Wide-field fundus photograph of an infant: 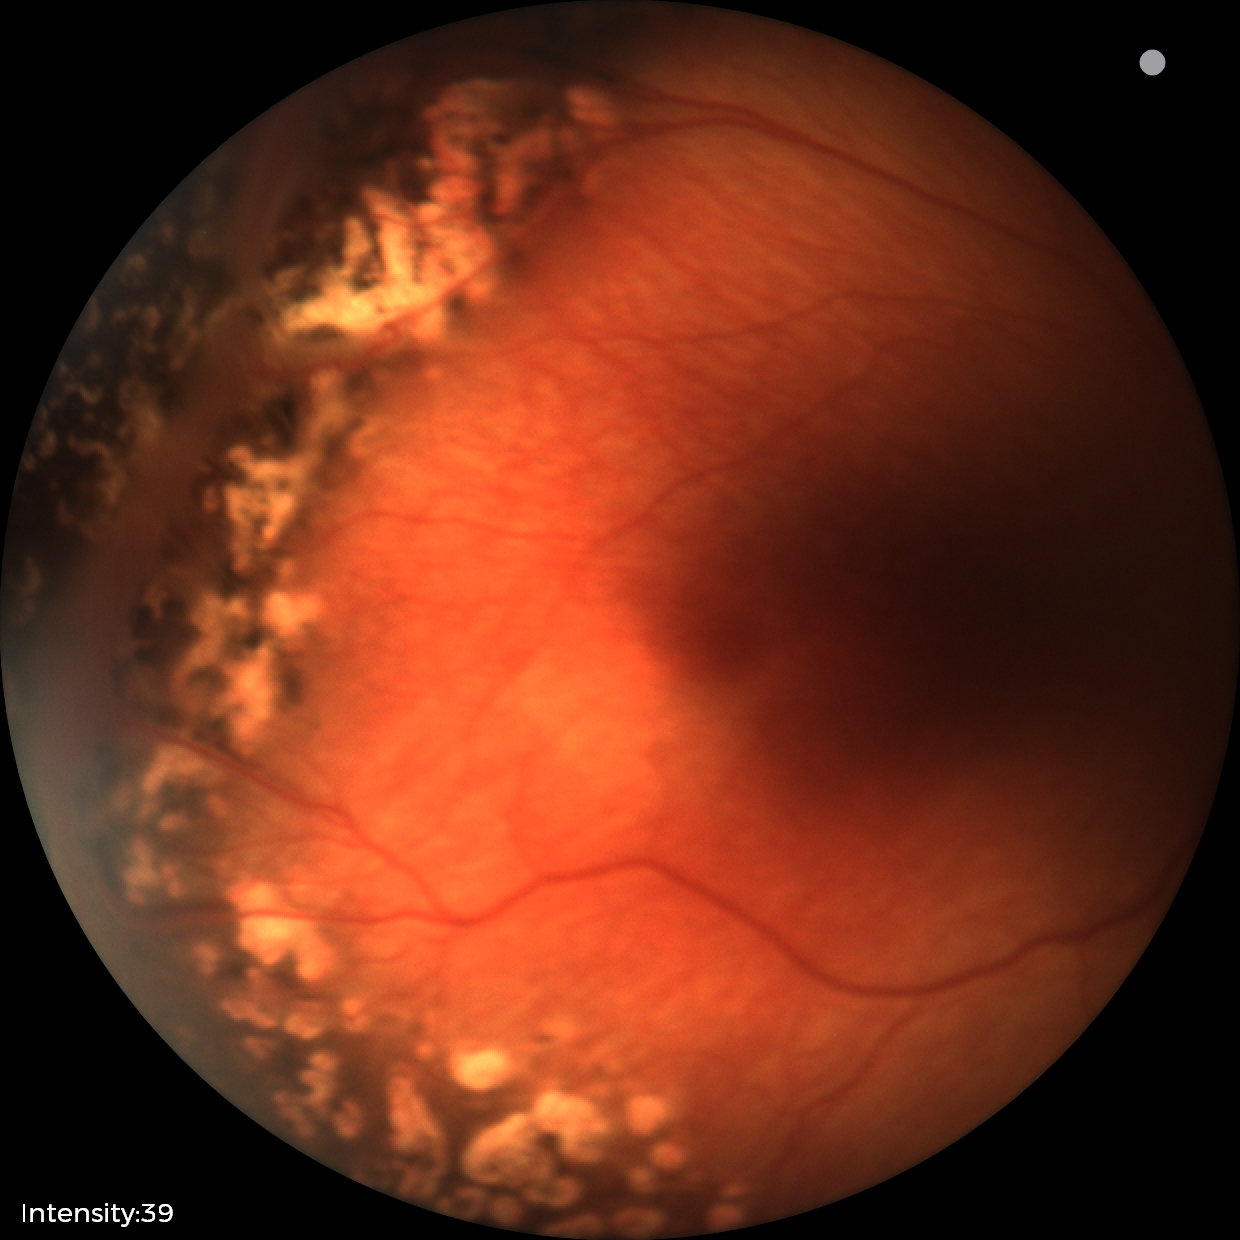 Examination diagnosed as status post retinopathy of prematurity. Without plus disease.